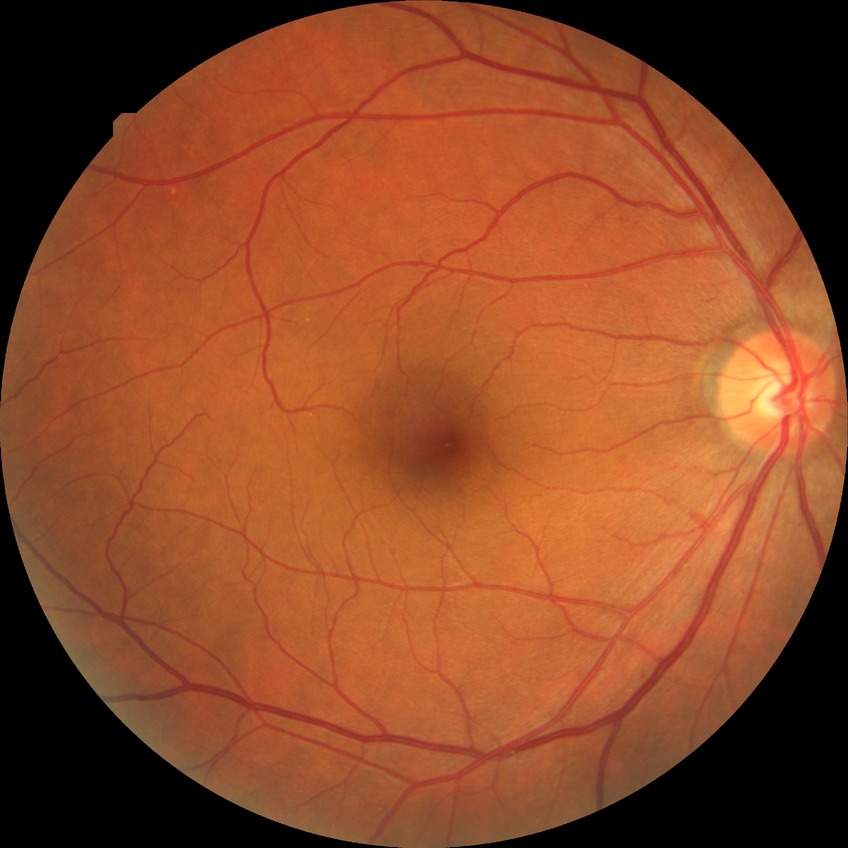 modified Davis grading: no diabetic retinopathy.